Diabetic retinopathy graded by the modified Davis classification:
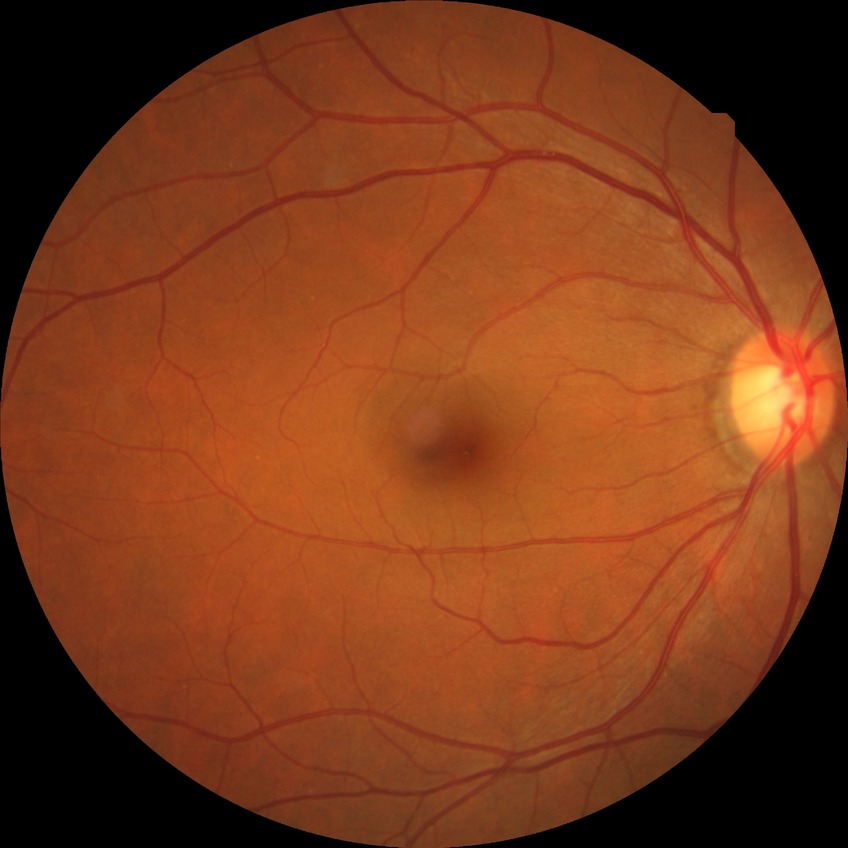
Diabetic retinopathy (DR) is no diabetic retinopathy (NDR).